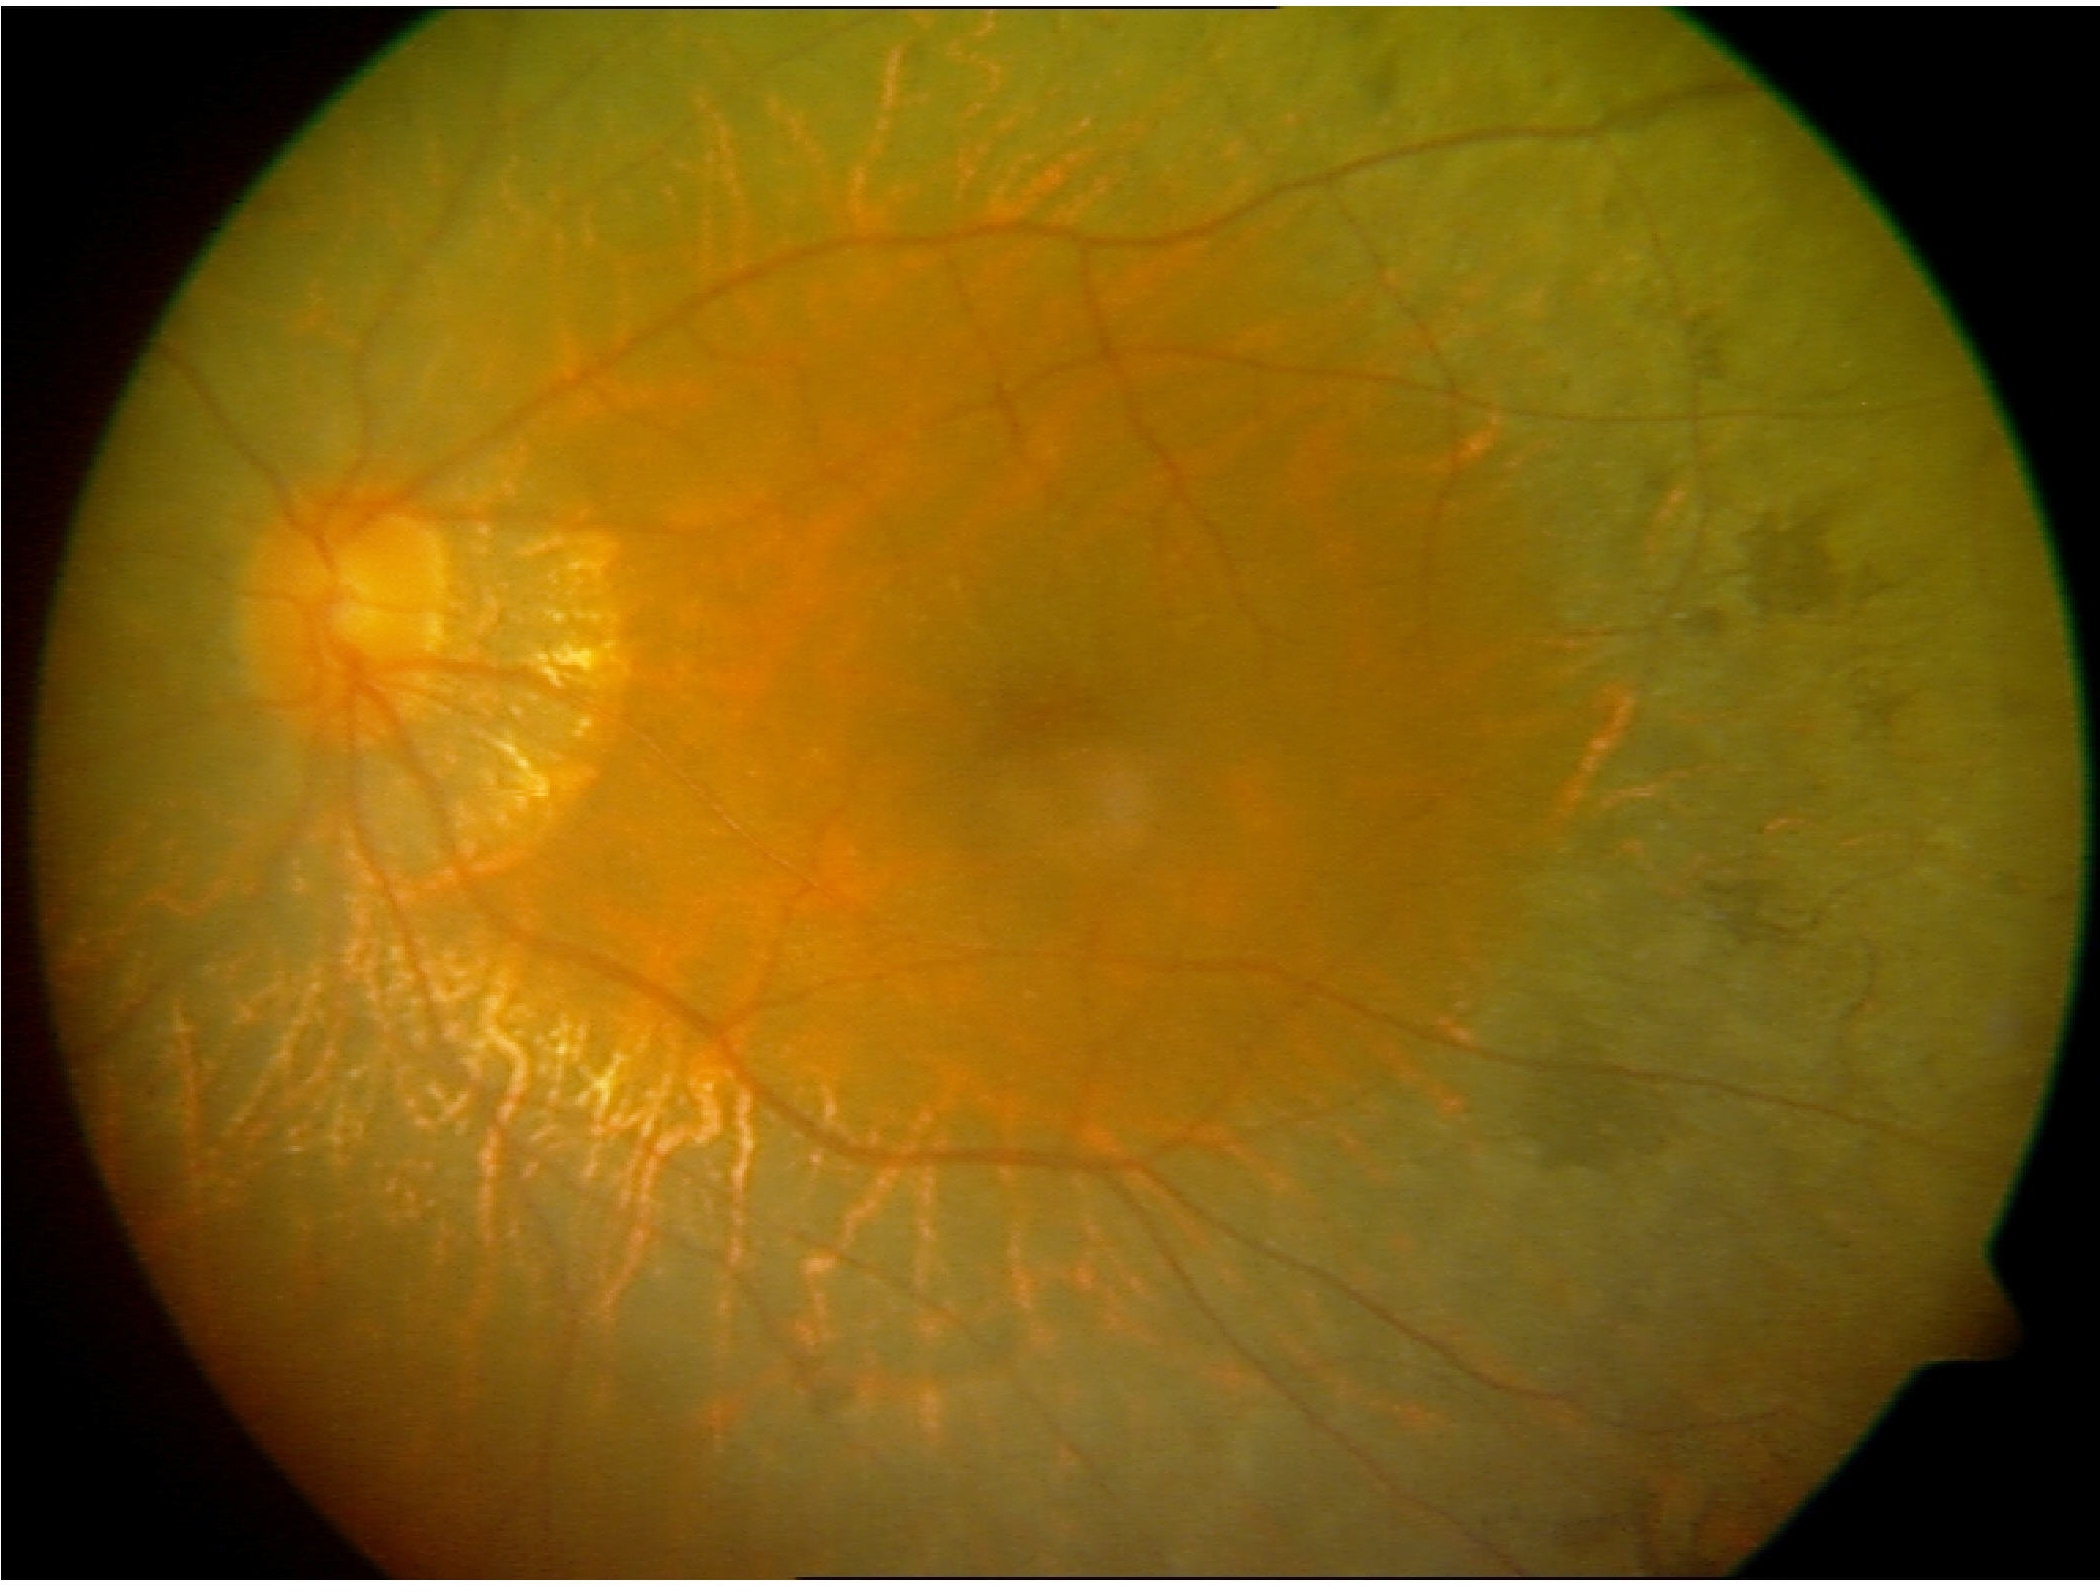
Findings consistent with retinitis pigmentosa.